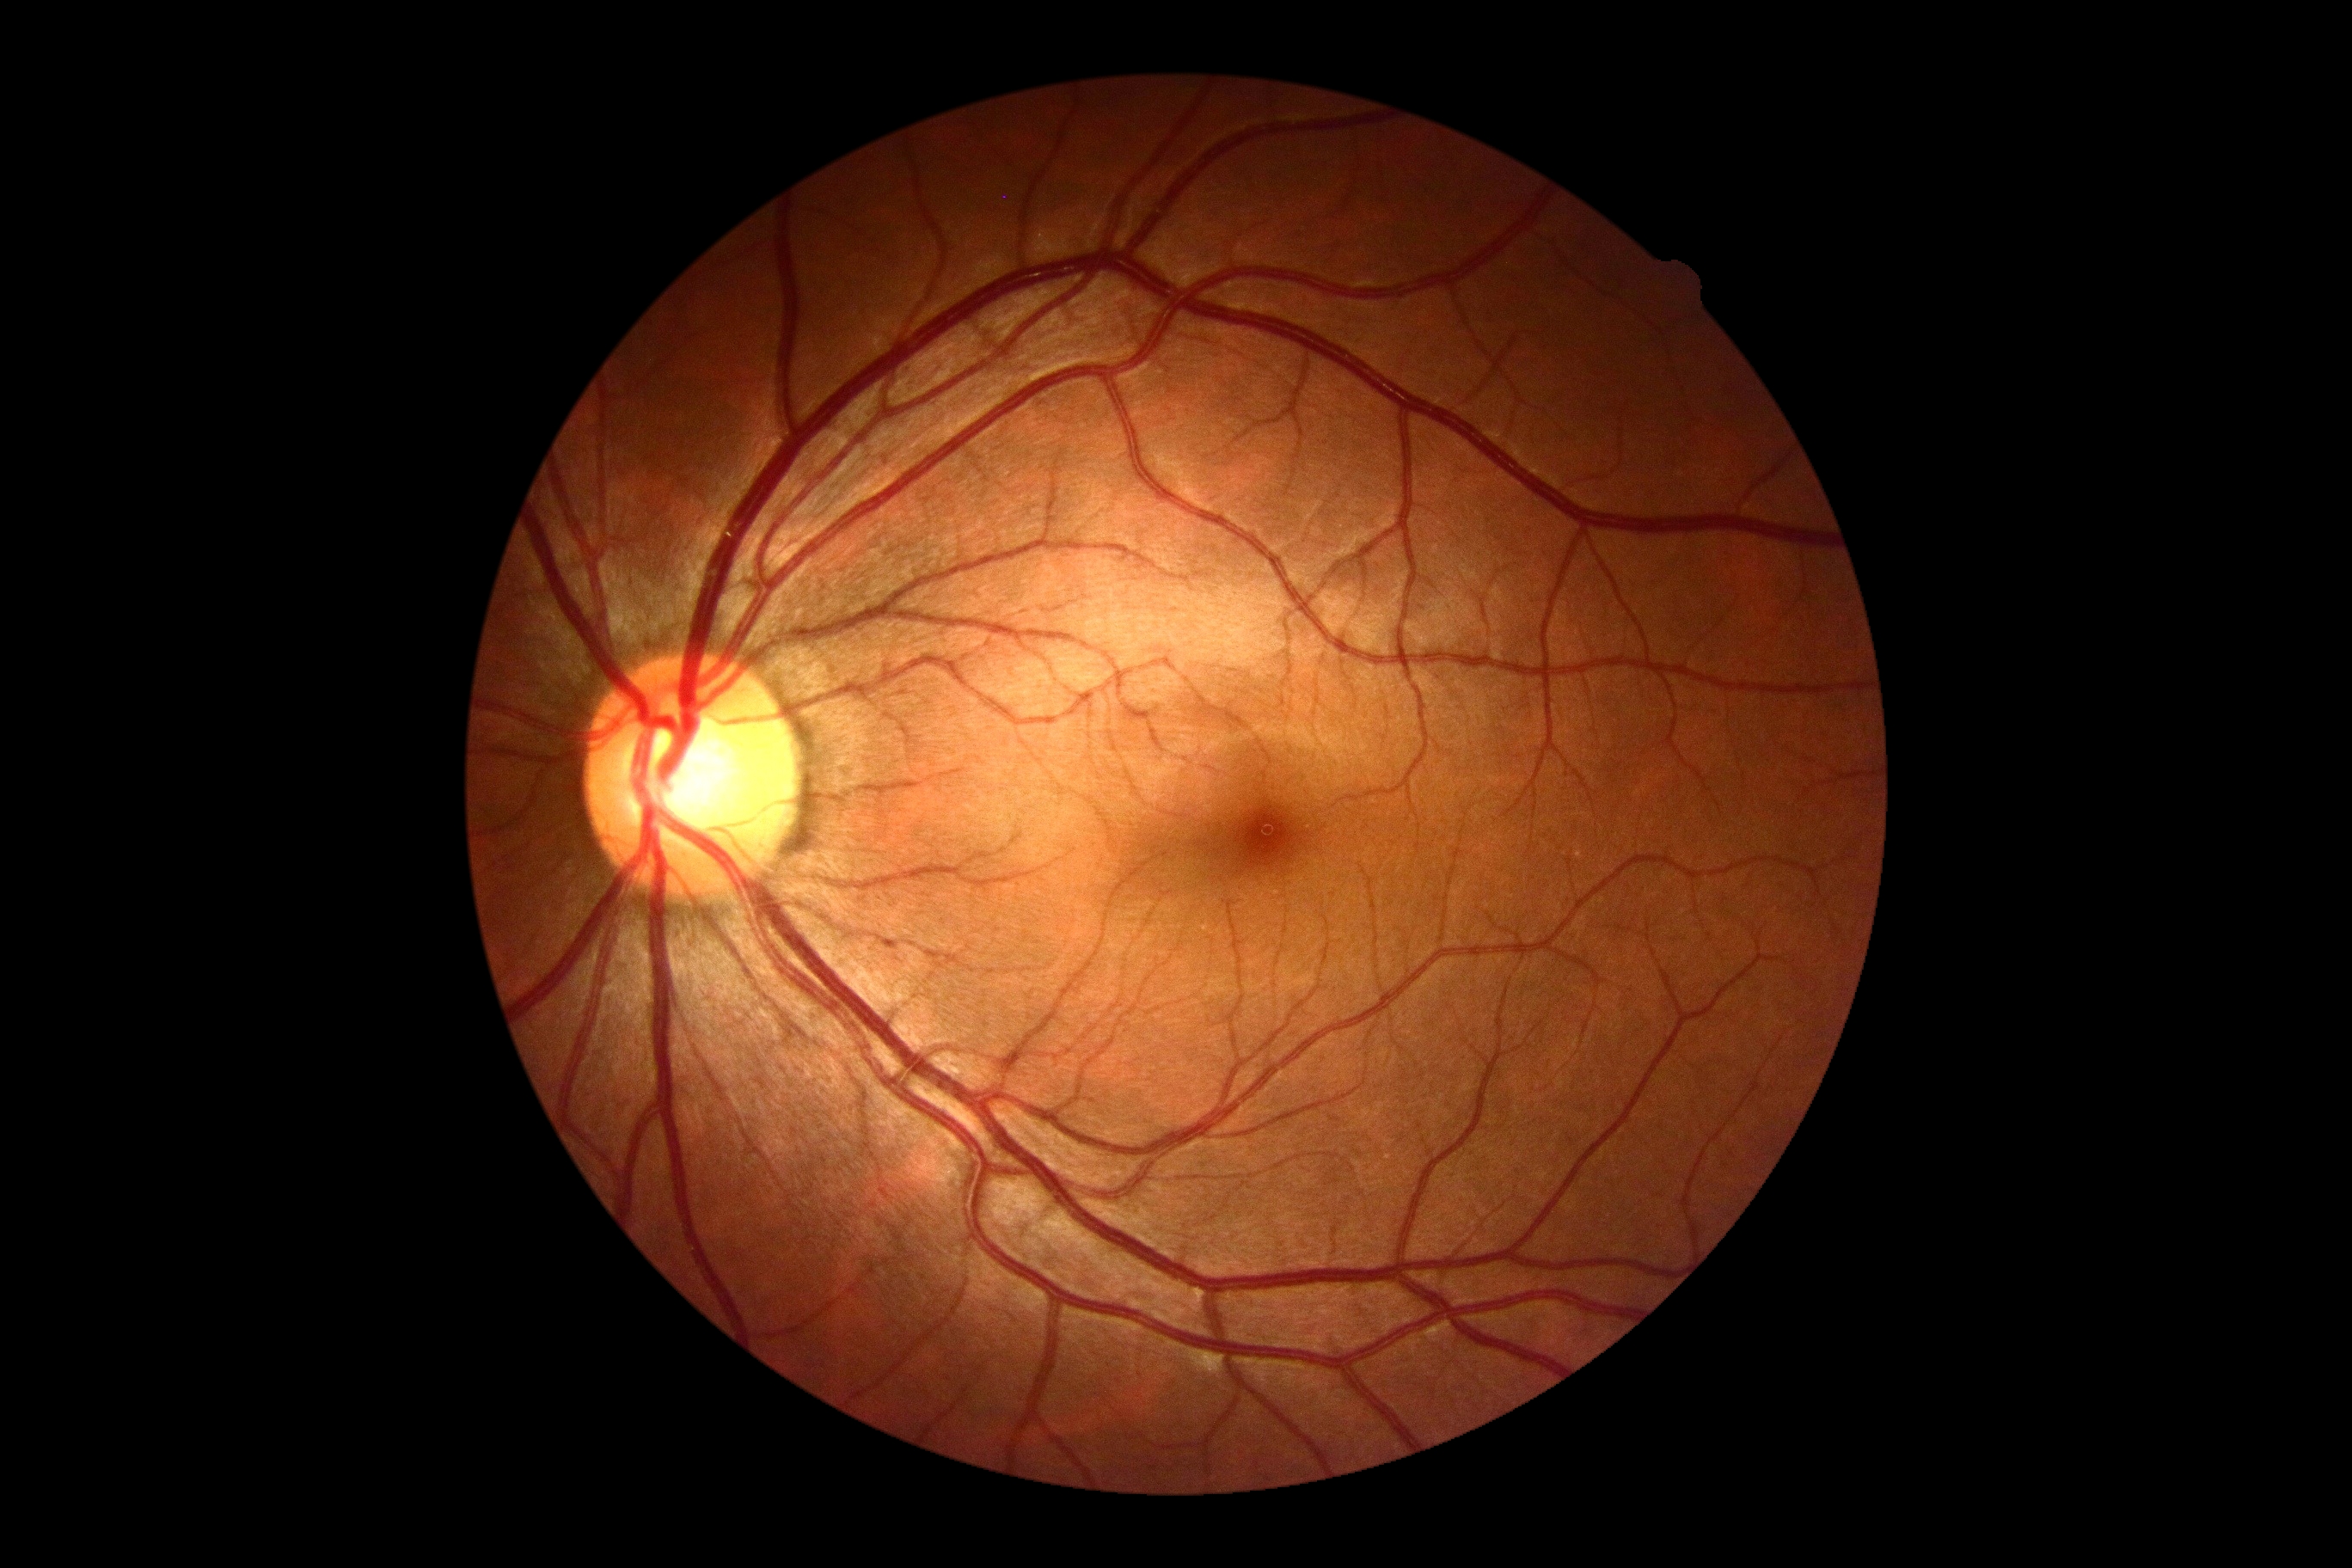
DR stage is grade 0 (no apparent retinopathy).